45-degree field of view:
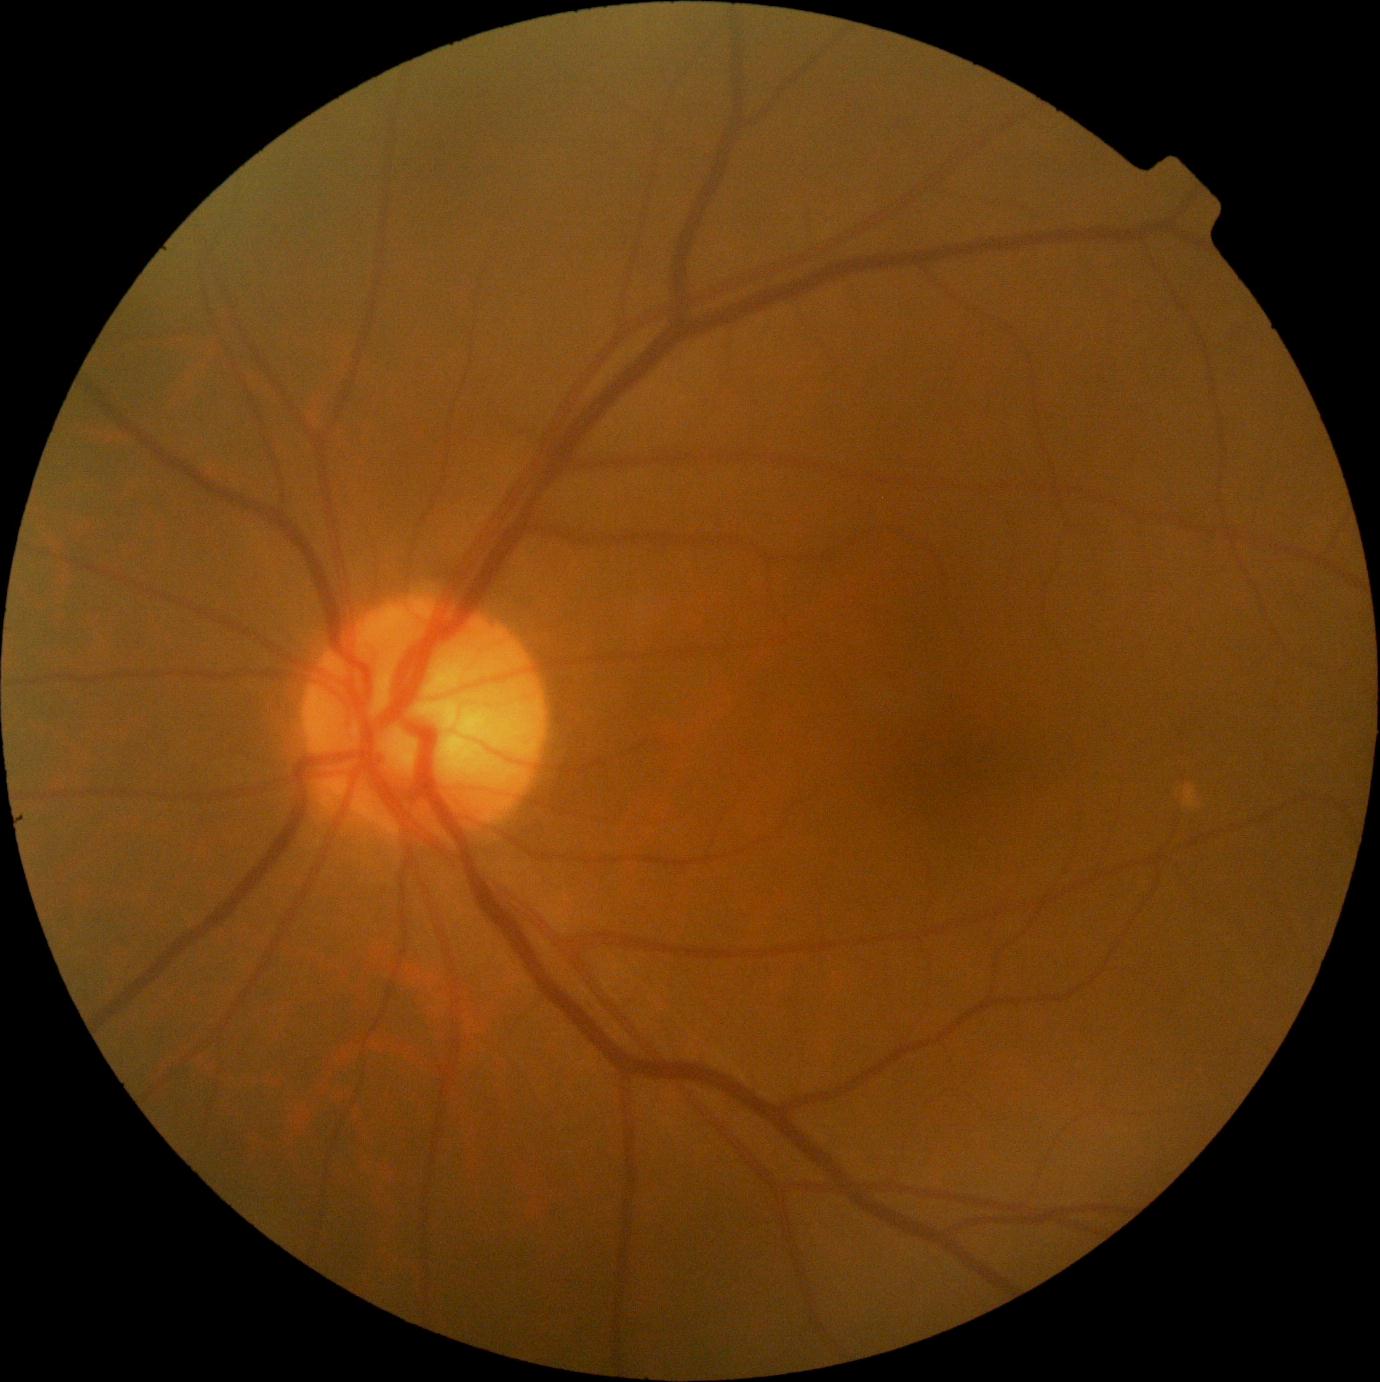

{
  "dr_impression": "no signs of DR",
  "dr_grade": "0 — no visible signs of diabetic retinopathy"
}